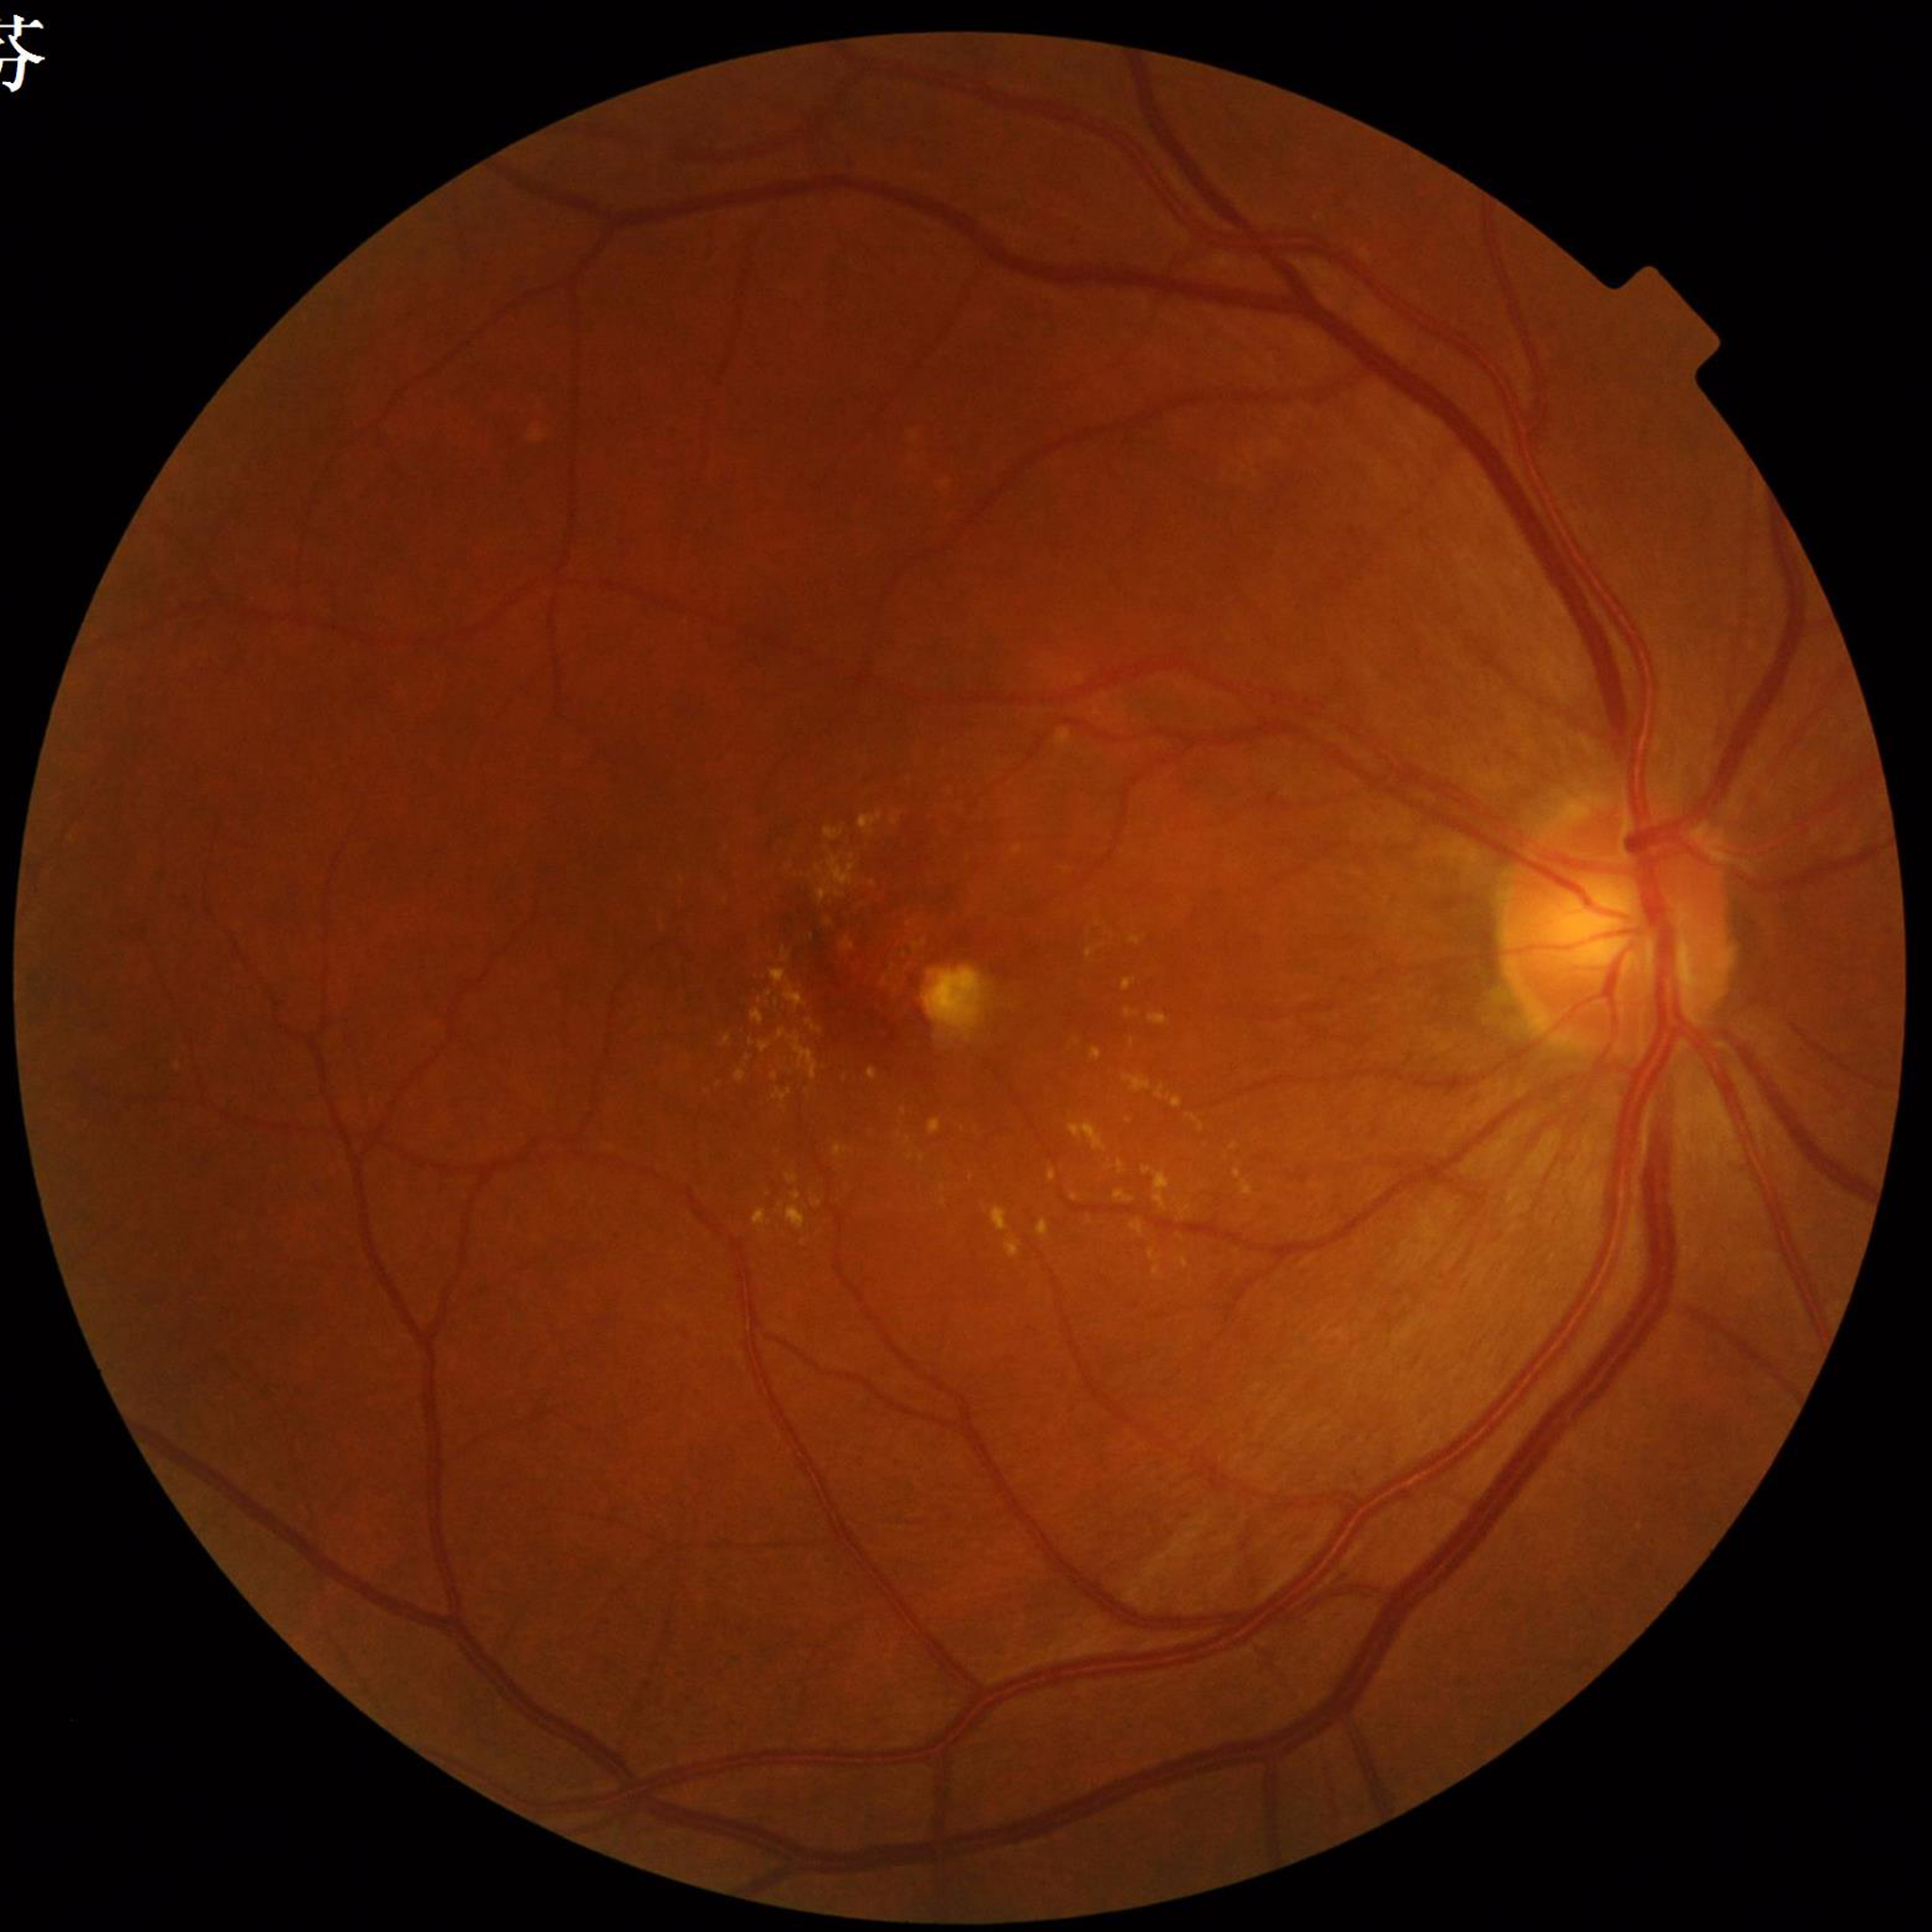
Color fundus photograph from a patient diagnosed with age-related macular degeneration.